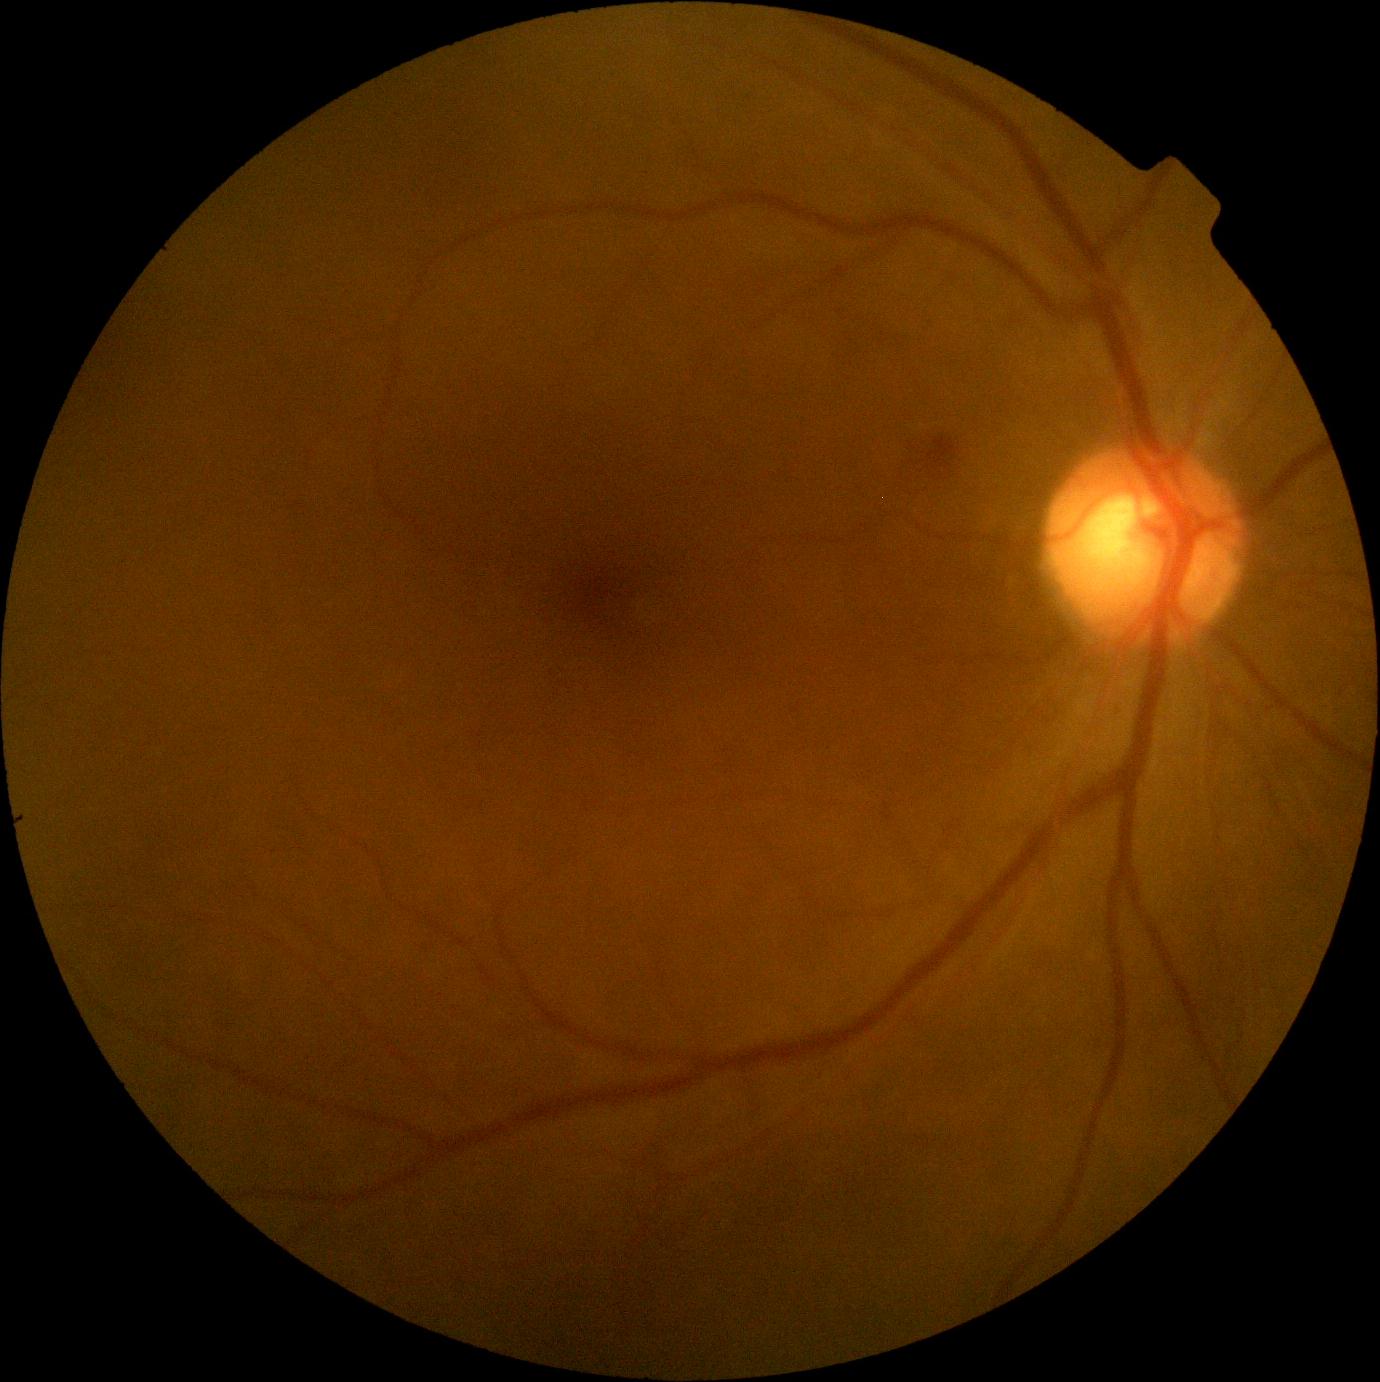
retinopathy grade = 2.